No pharmacologic dilation · DR severity per modified Davis staging · NIDEK AFC-230 · color fundus image.
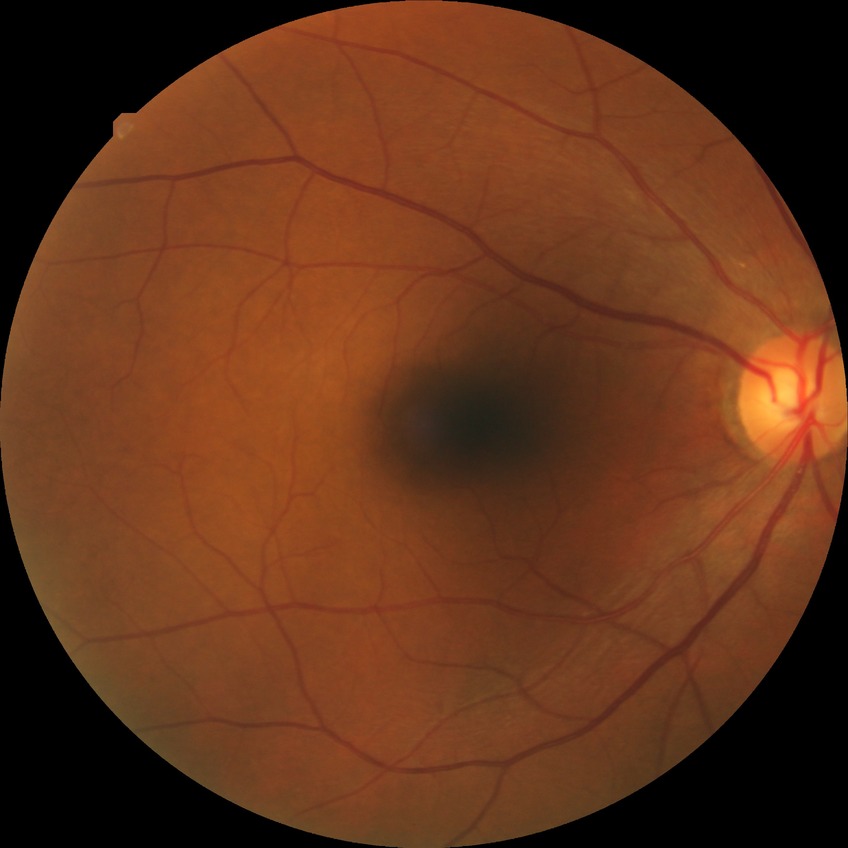

modified Davis grading: no diabetic retinopathy.